2102 x 1736 pixels:
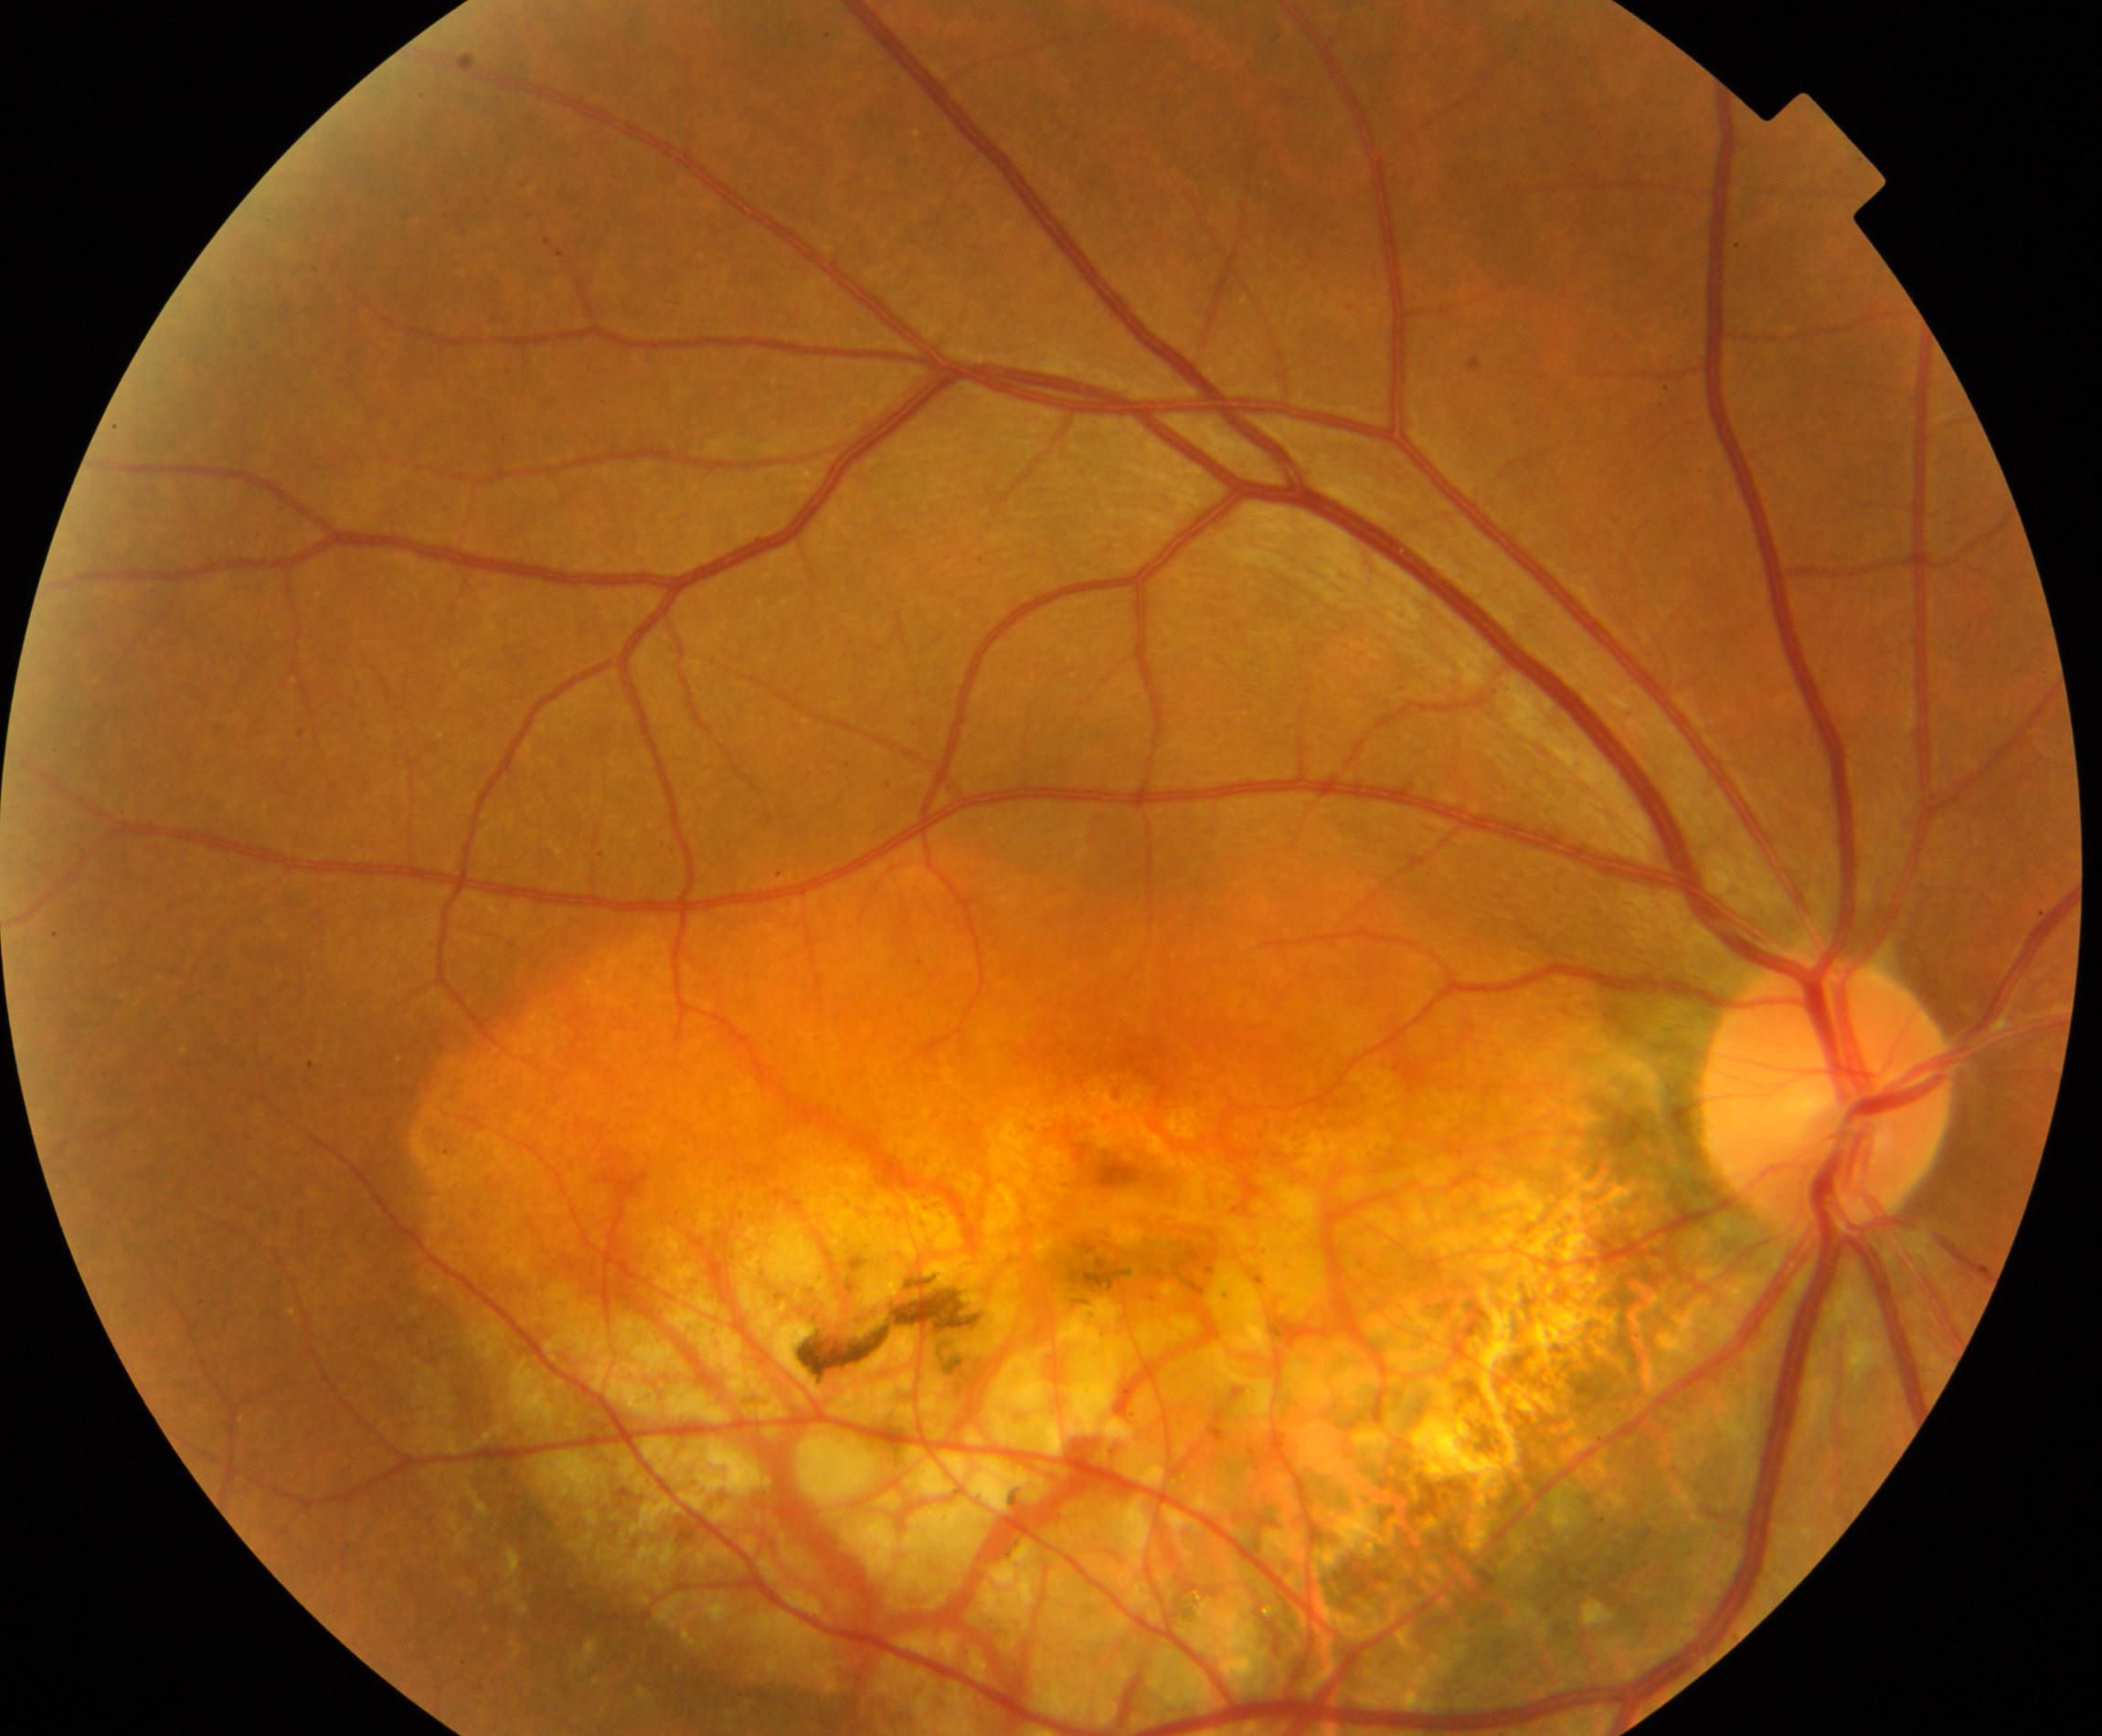 Primary finding: fundus neoplasm.